45° field of view. 2048 by 1536 pixels. Fundus photo
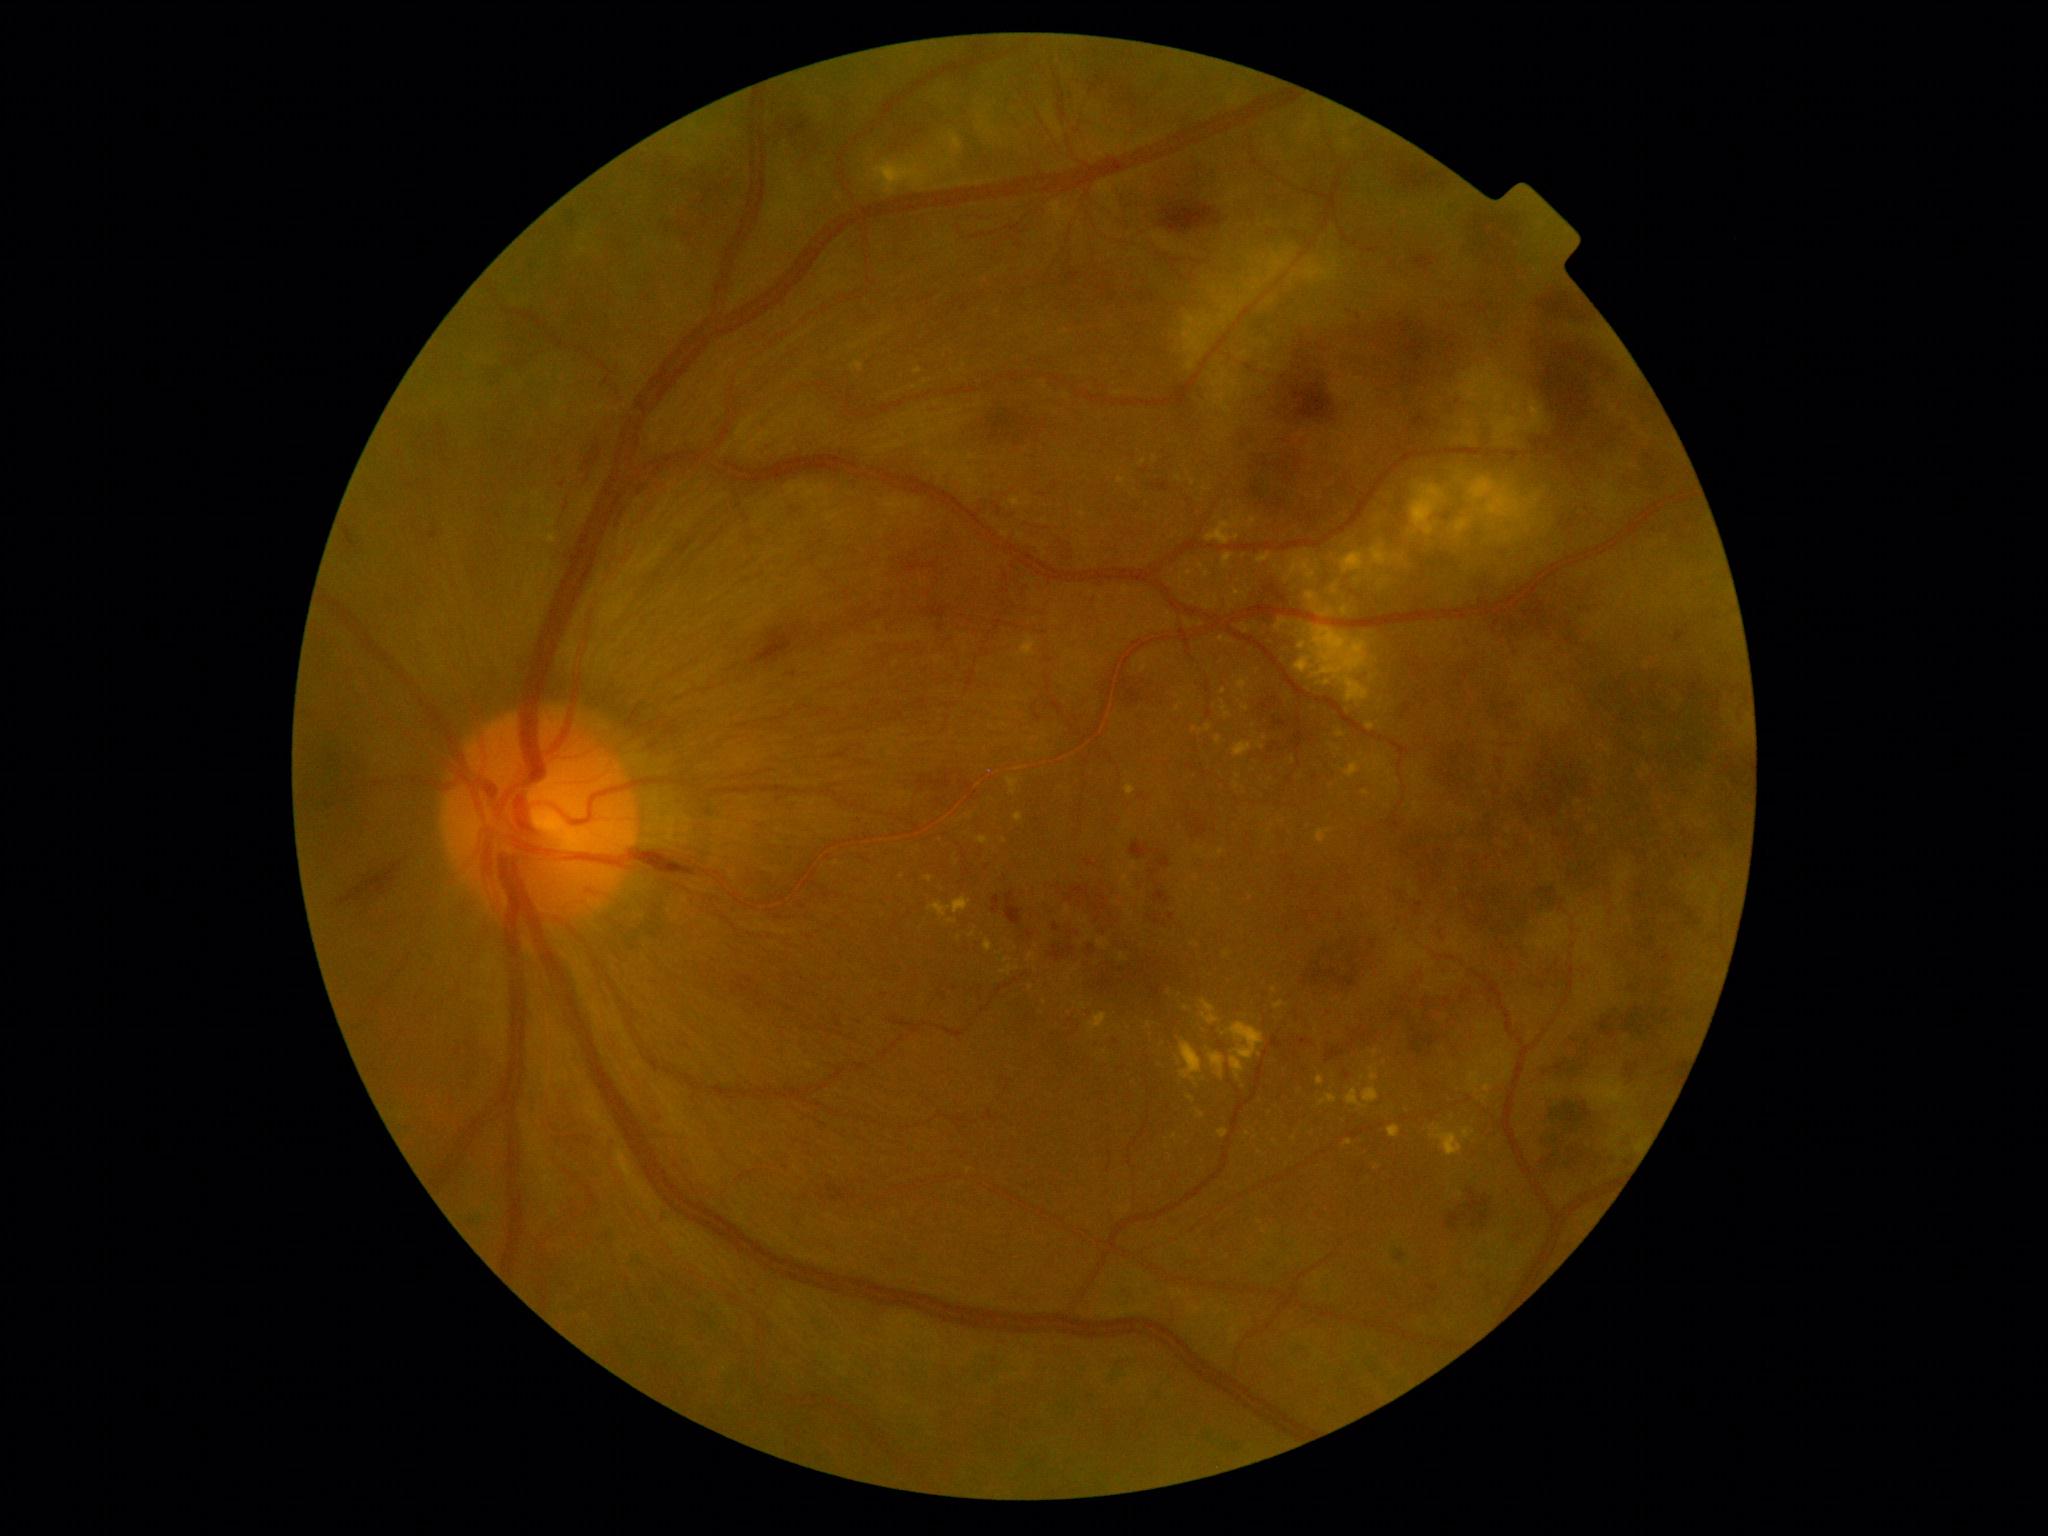 <lesions partial="true">
  <dr_grade>4</dr_grade>
  <ex partial="true">[547,518,557,527] | [1317,1075,1324,1085] | [1363,1083,1379,1104] | [1240,624,1253,634] | [1241,706,1250,712] | [1171,238,1350,438] | [1001,965,1021,975] | [1234,590,1249,600] | [928,898,972,919]</ex>
  <ex_small_approx>(1238; 777) | (1143; 462) | (1084; 1007) | (1132; 914) | (1135; 894) | (1189; 624) | (1266; 738) | (1177; 709) | (1271; 1113)</ex_small_approx>
  <he partial="true">[650,1114,673,1131] | [1148,475,1180,497] | [429,531,438,540] | [1140,286,1161,309] | [816,1176,857,1206] | [1304,935,1379,994] | [1422,1280,1449,1304] | [988,828,1193,997] | [1442,1180,1498,1233] | [1461,205,1539,278] | [1322,966,1428,1064] | [1230,294,1705,547] | [1115,679,1174,720] | [335,855,408,904]</he>
  <he_small_approx>(559; 529)</he_small_approx>
</lesions>